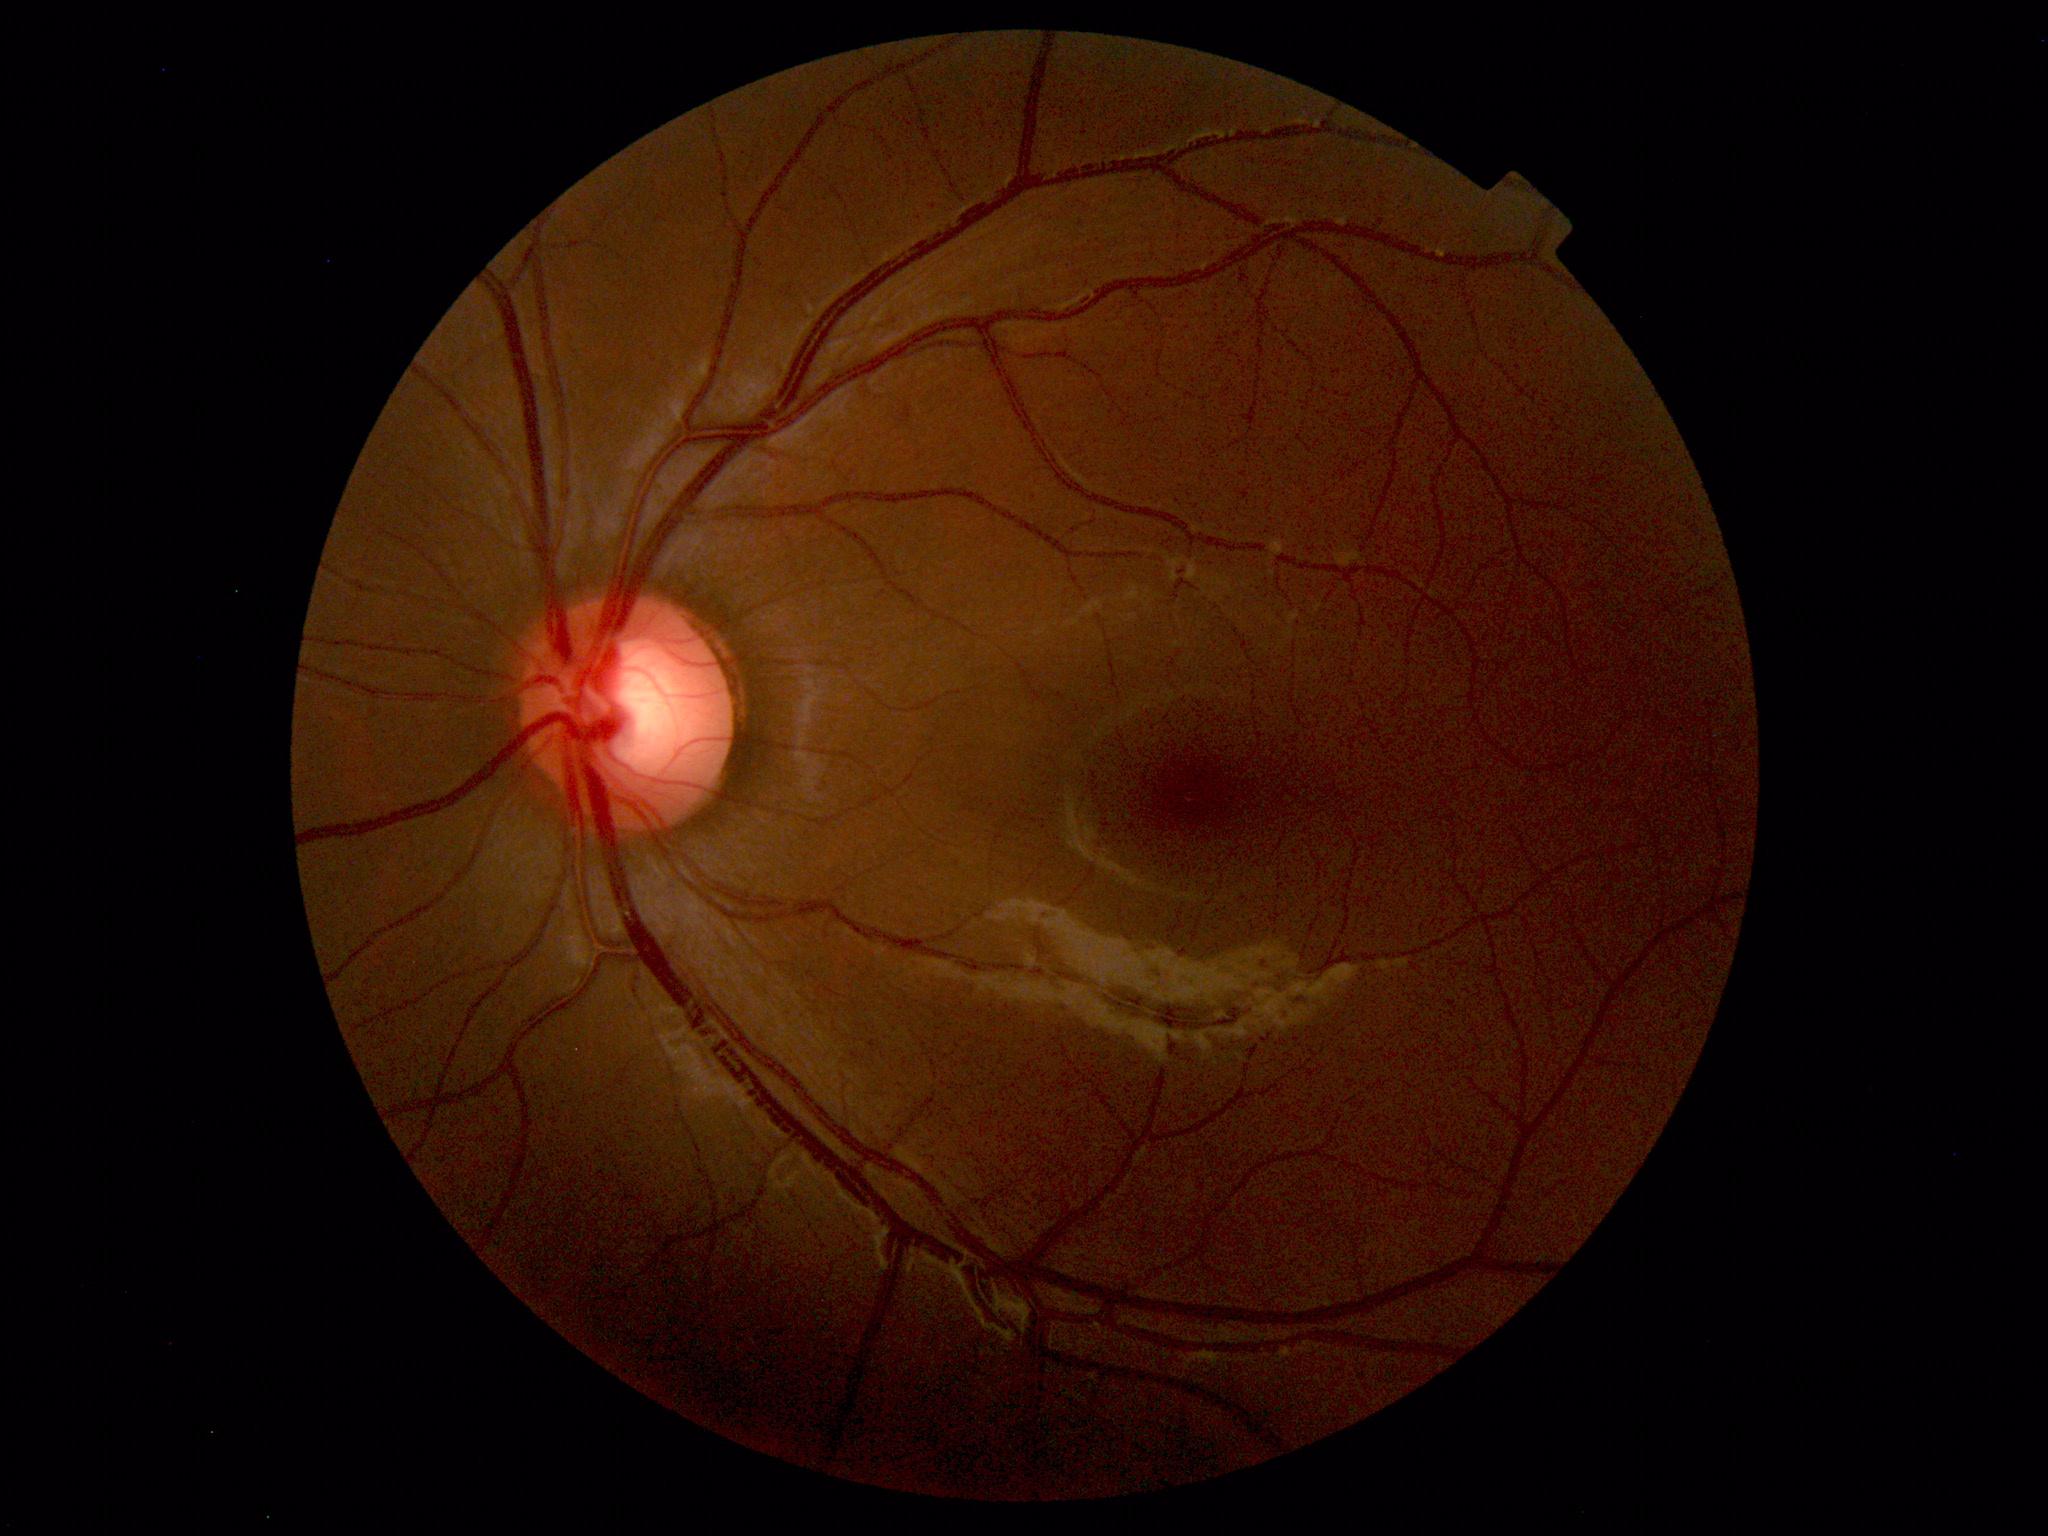 Within normal limits. No abnormalities identified.